Davis DR grading: 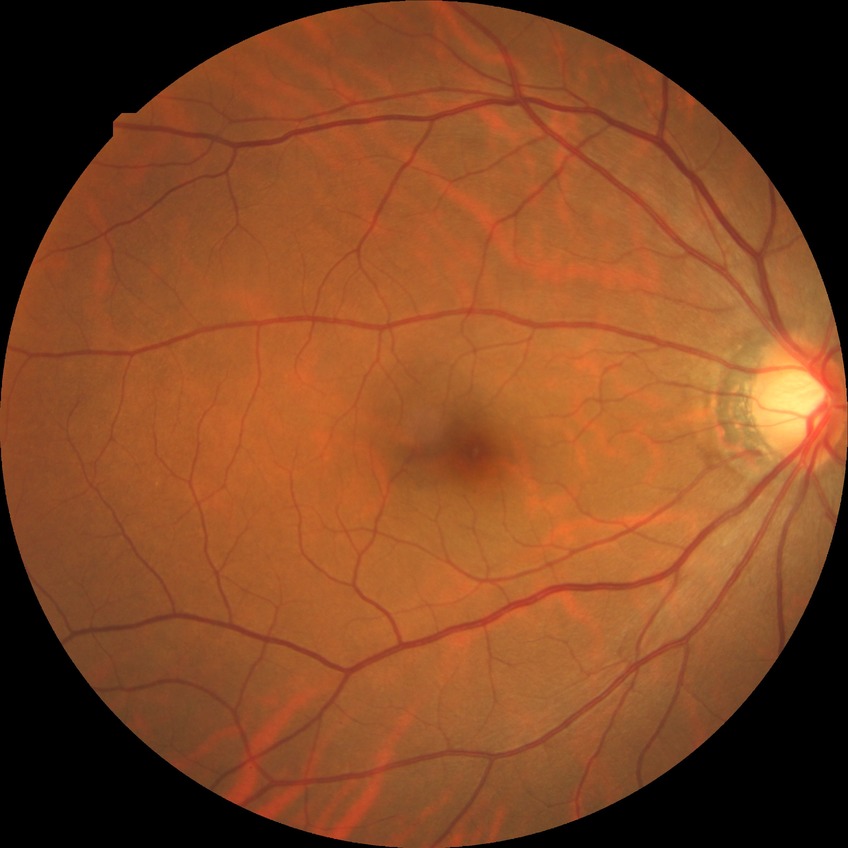 Diabetic retinopathy (DR): no diabetic retinopathy (NDR).